1659 by 2212 pixels: 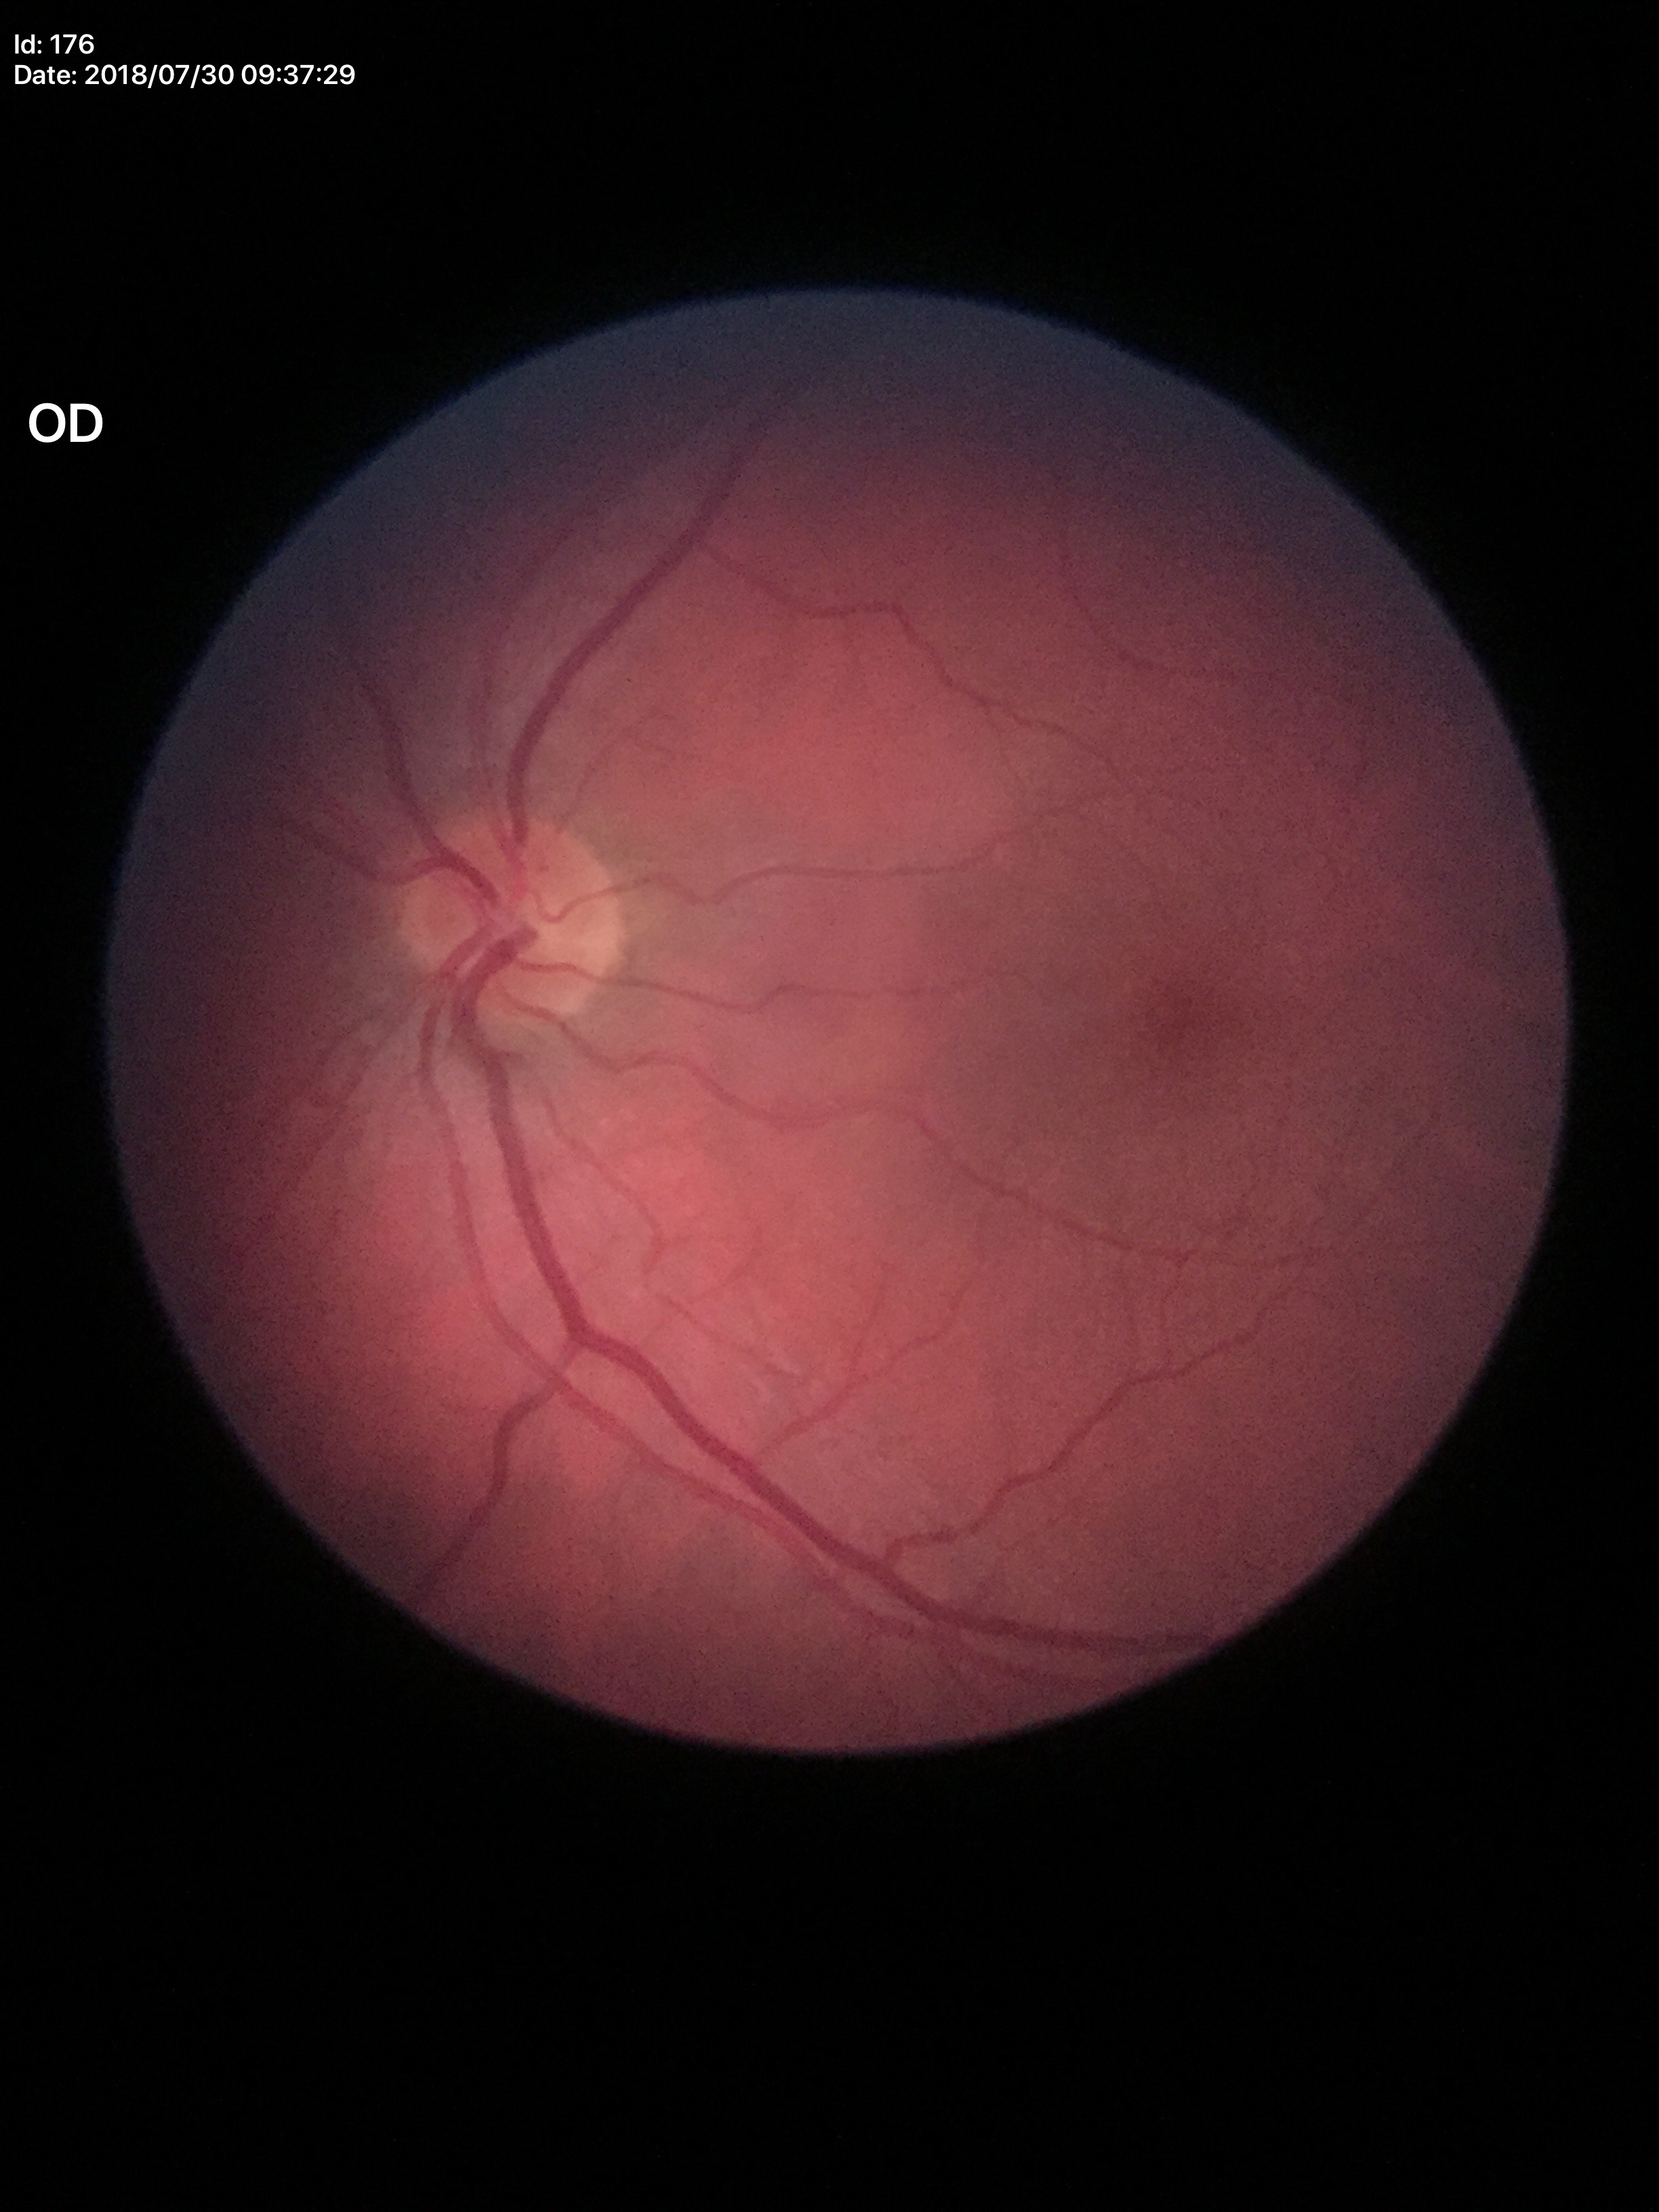
No signs of glaucoma.
Vertical CDR: 0.47.